Pediatric wide-field fundus photograph: 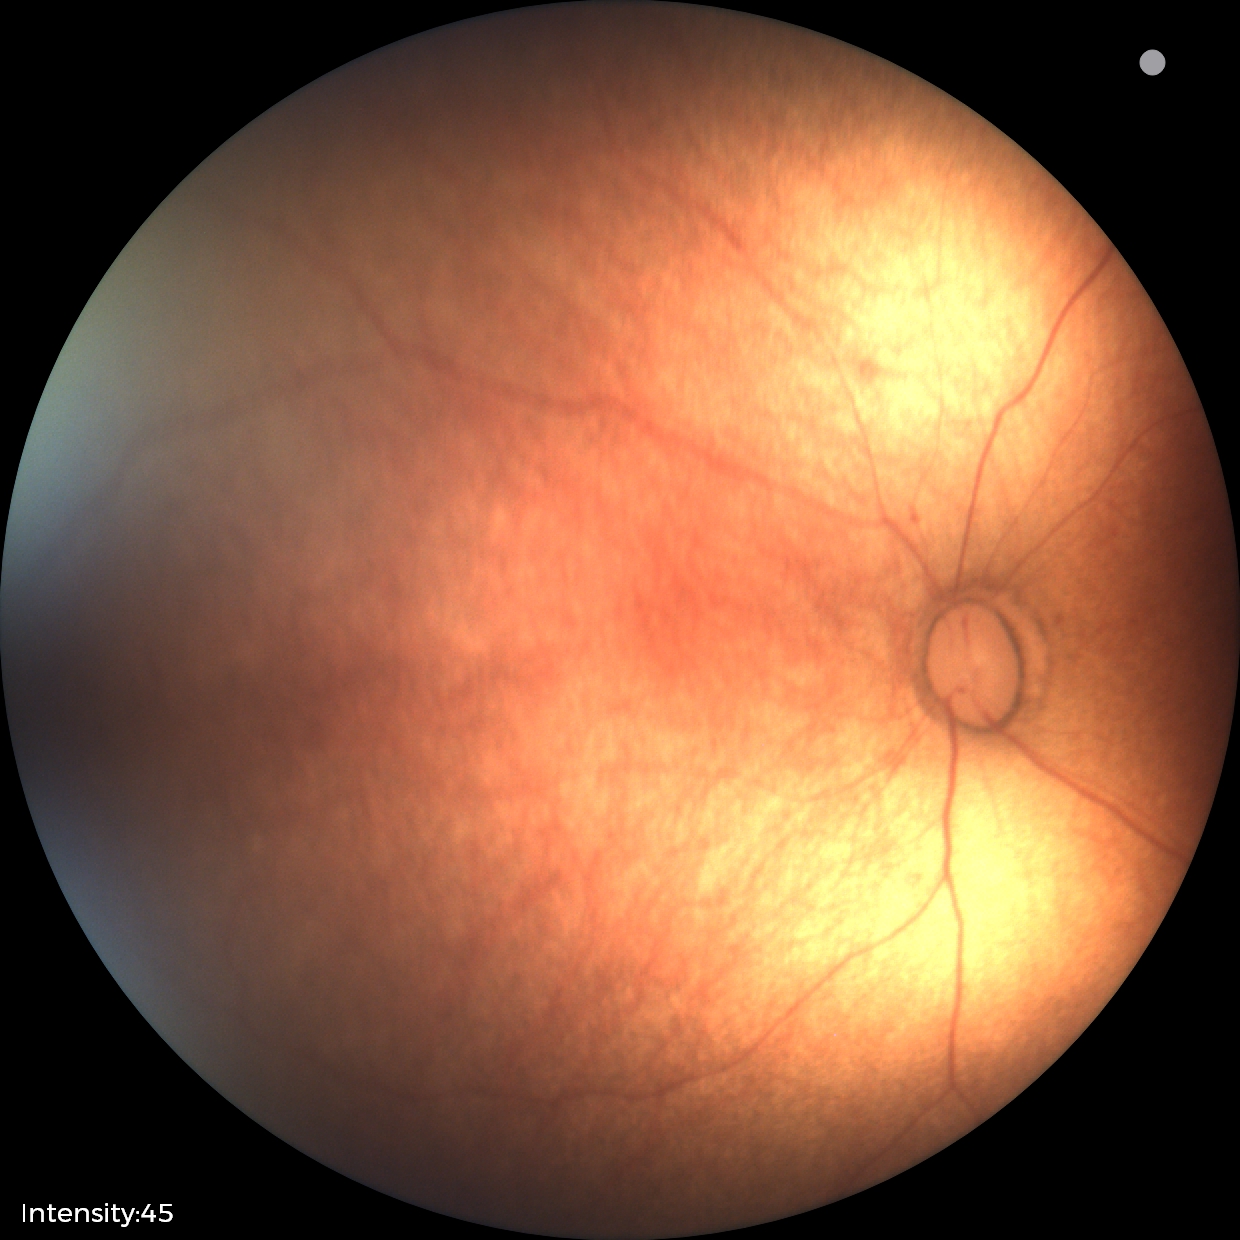

Physiological retinal appearance for postconceptual age.